45° field of view, retinal fundus photograph:
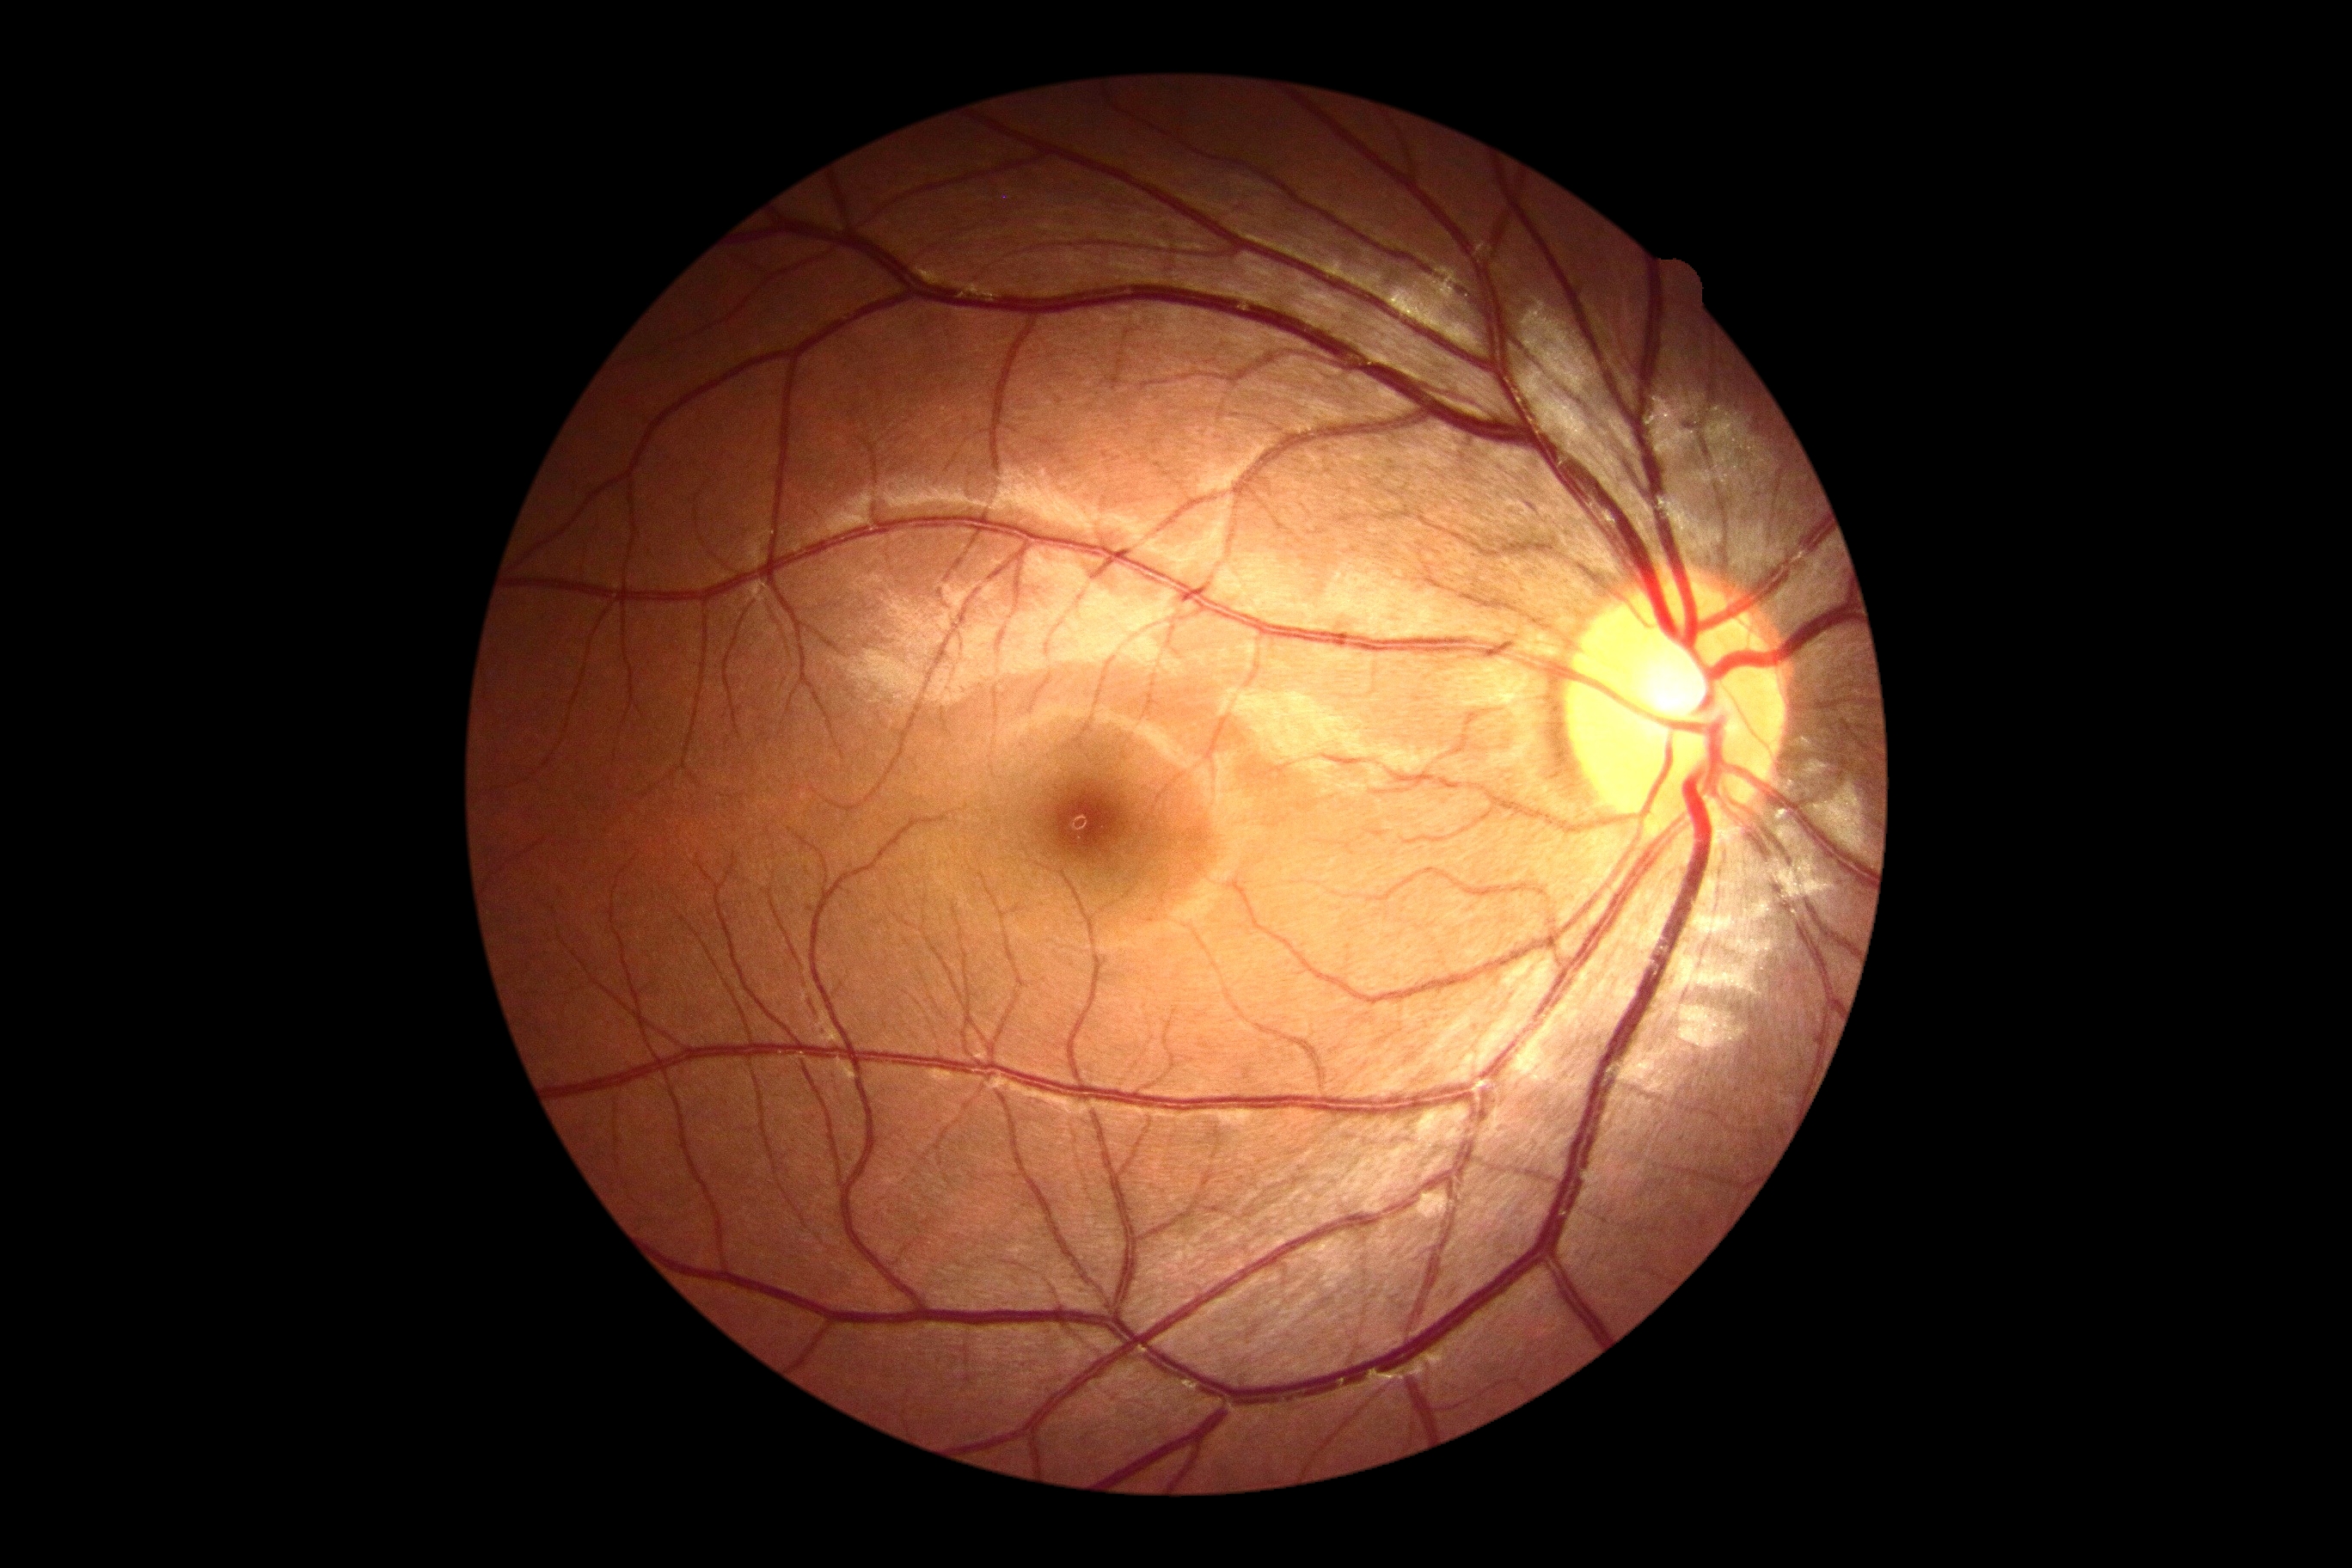 DR impression: no apparent DR | DR grade: no apparent diabetic retinopathy (0).